Ultra-widefield fundus mosaic, image size 1924x1556, FOV: 200 degrees — 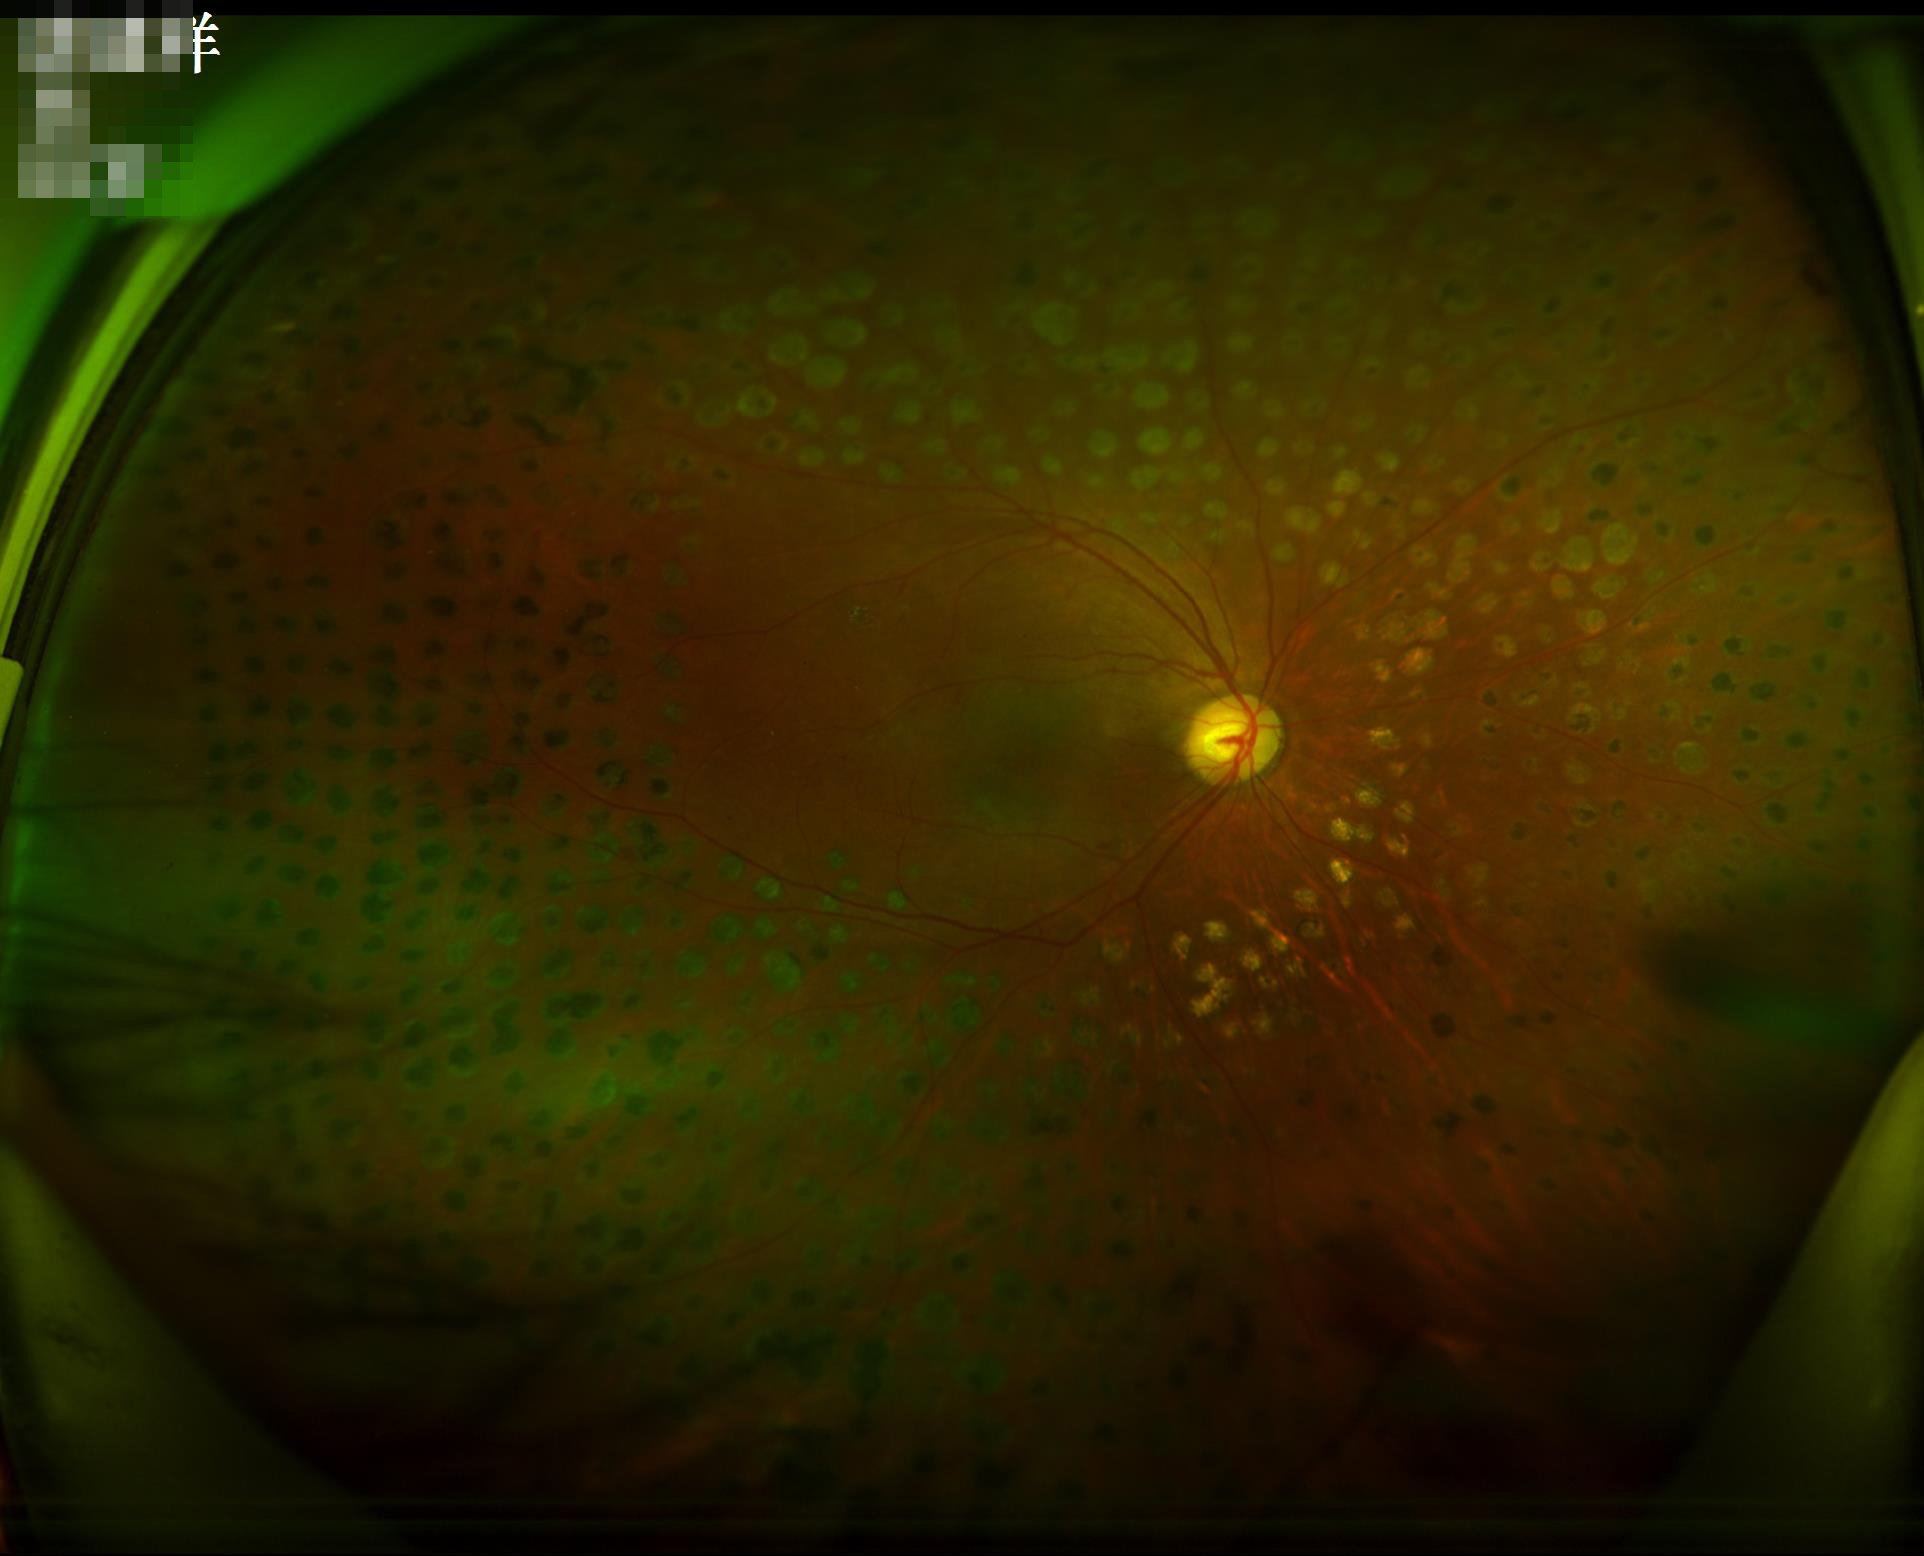
Overall quality is good and the image is gradable.
Image is sharp throughout the field.
There is over- or under-exposure or a color cast.
Vessels and details are readily distinguishable.